Camera: Remidio Fundus on Phone (FOP) camera — 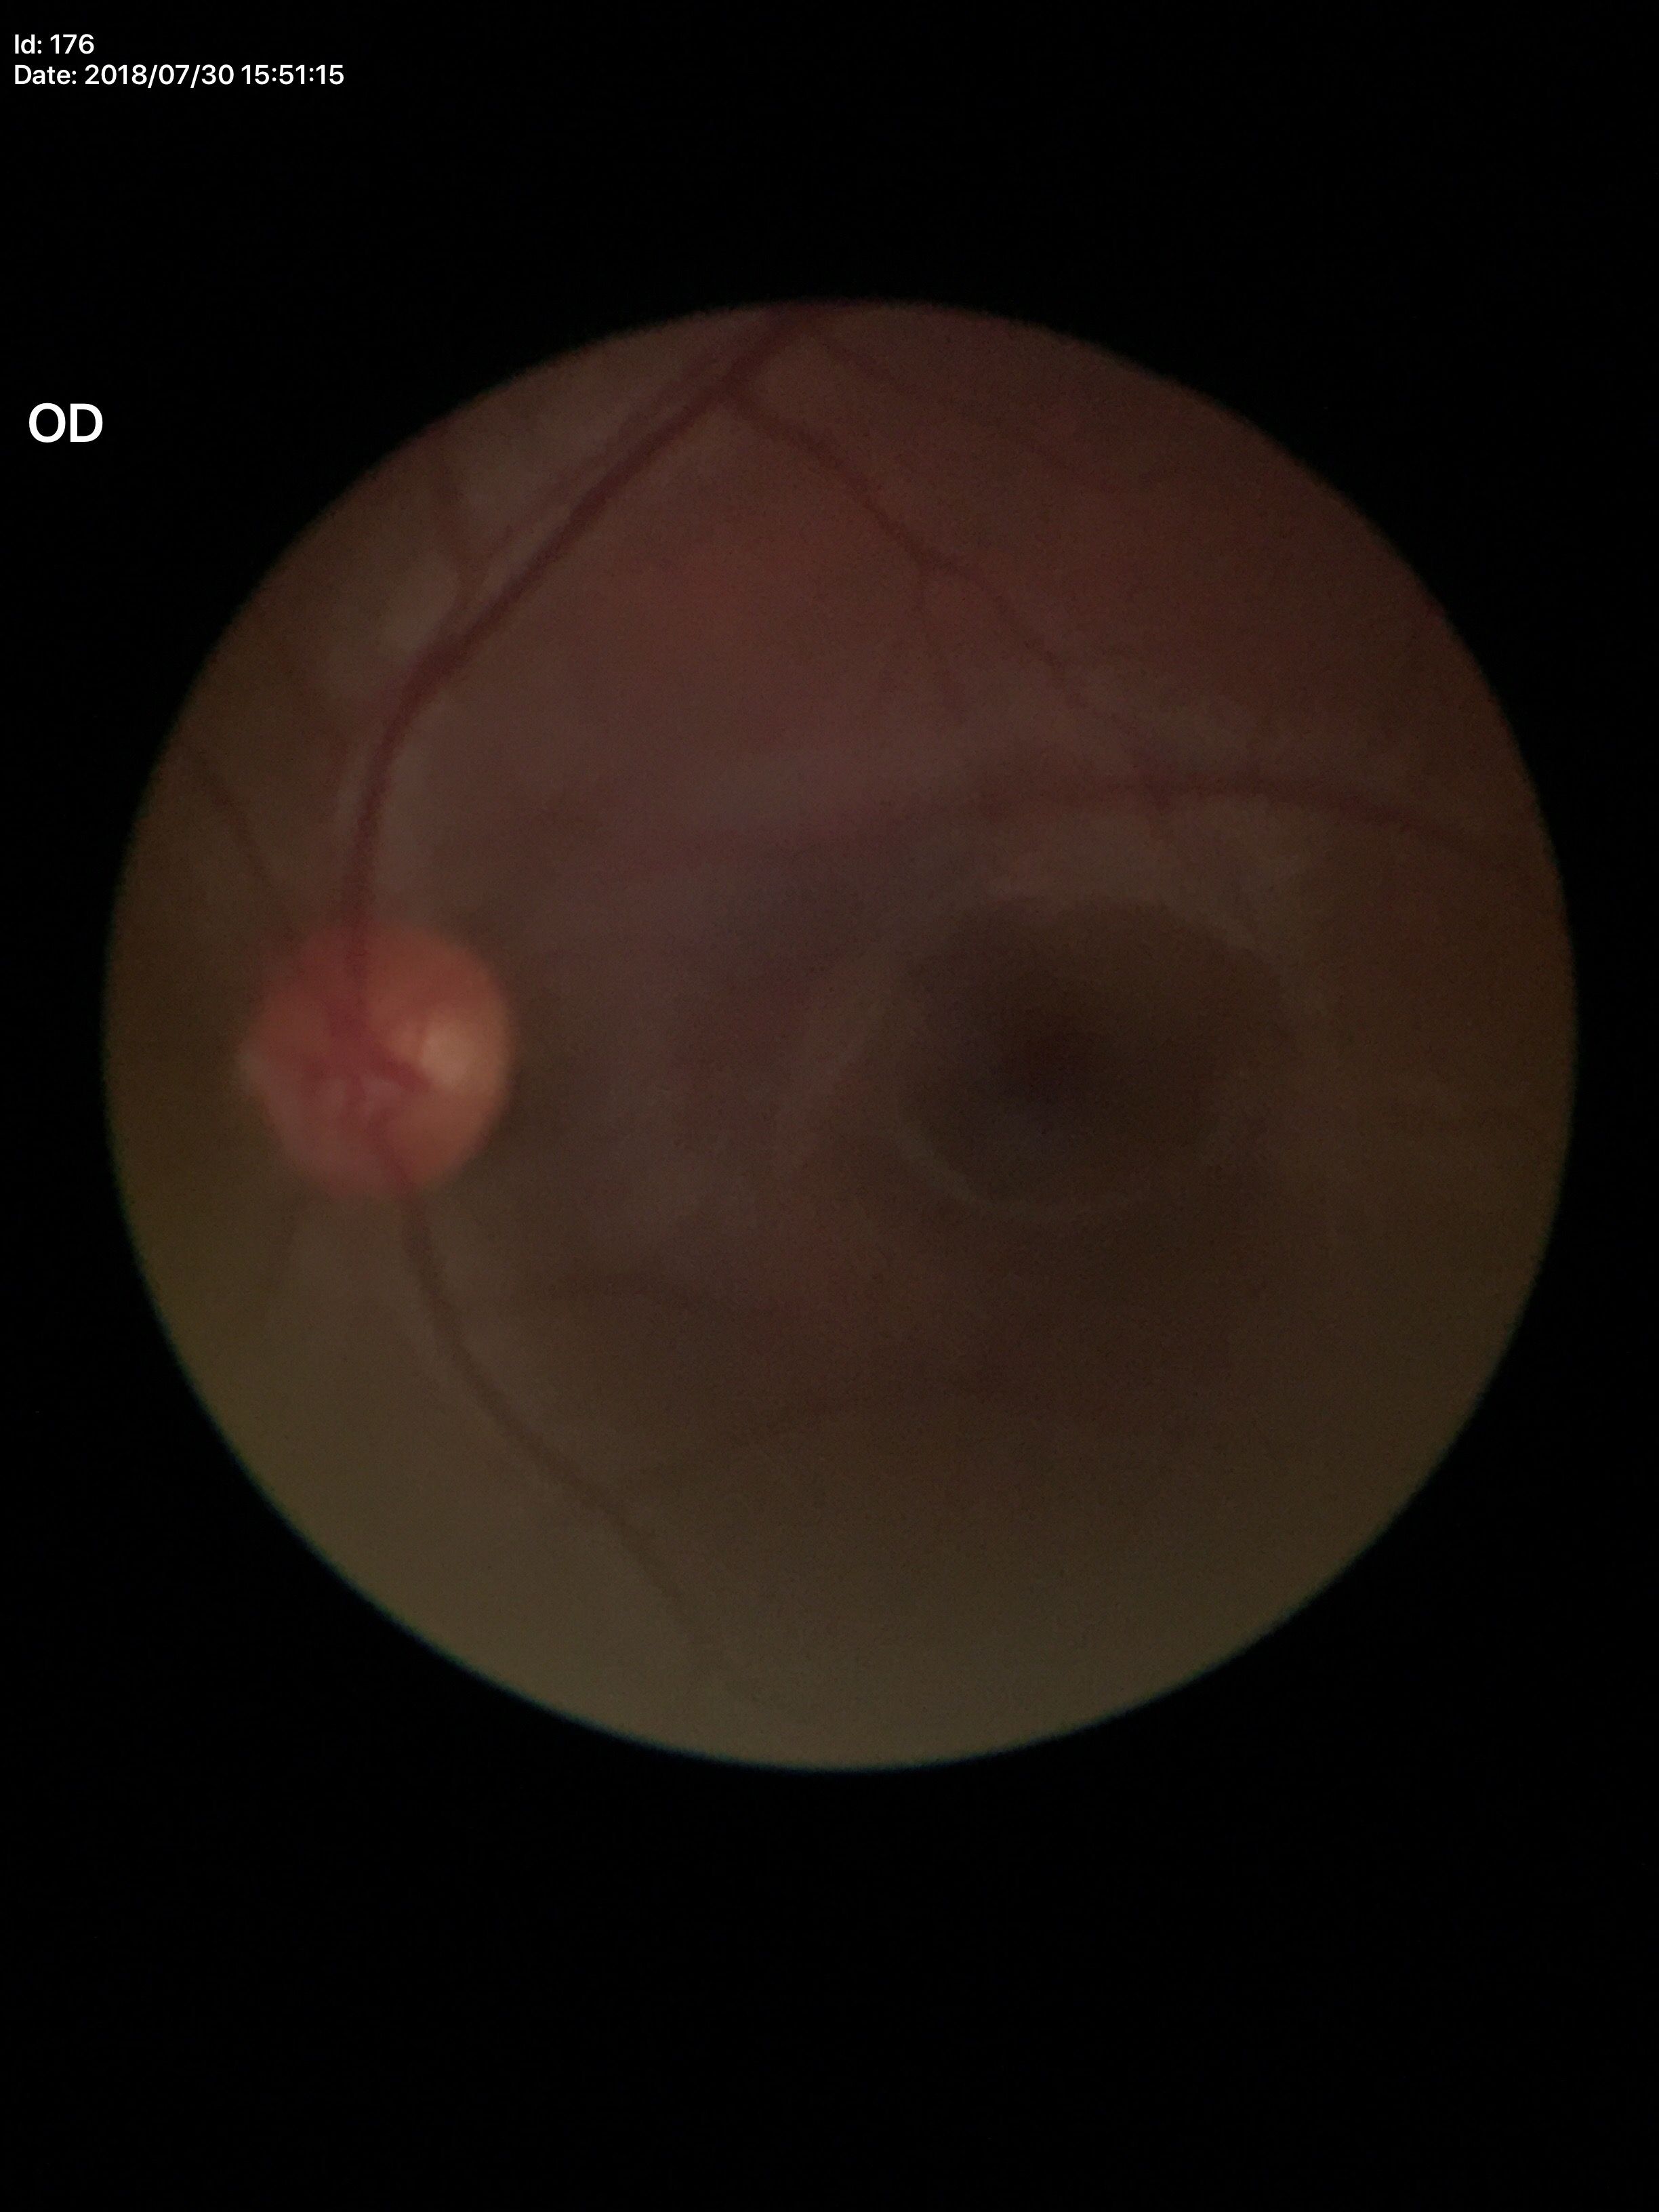

{"glaucoma_decision": "no suspicious findings", "acdr": "0.34", "vcdr": "0.55"}